CFP; image size 1932x1916: 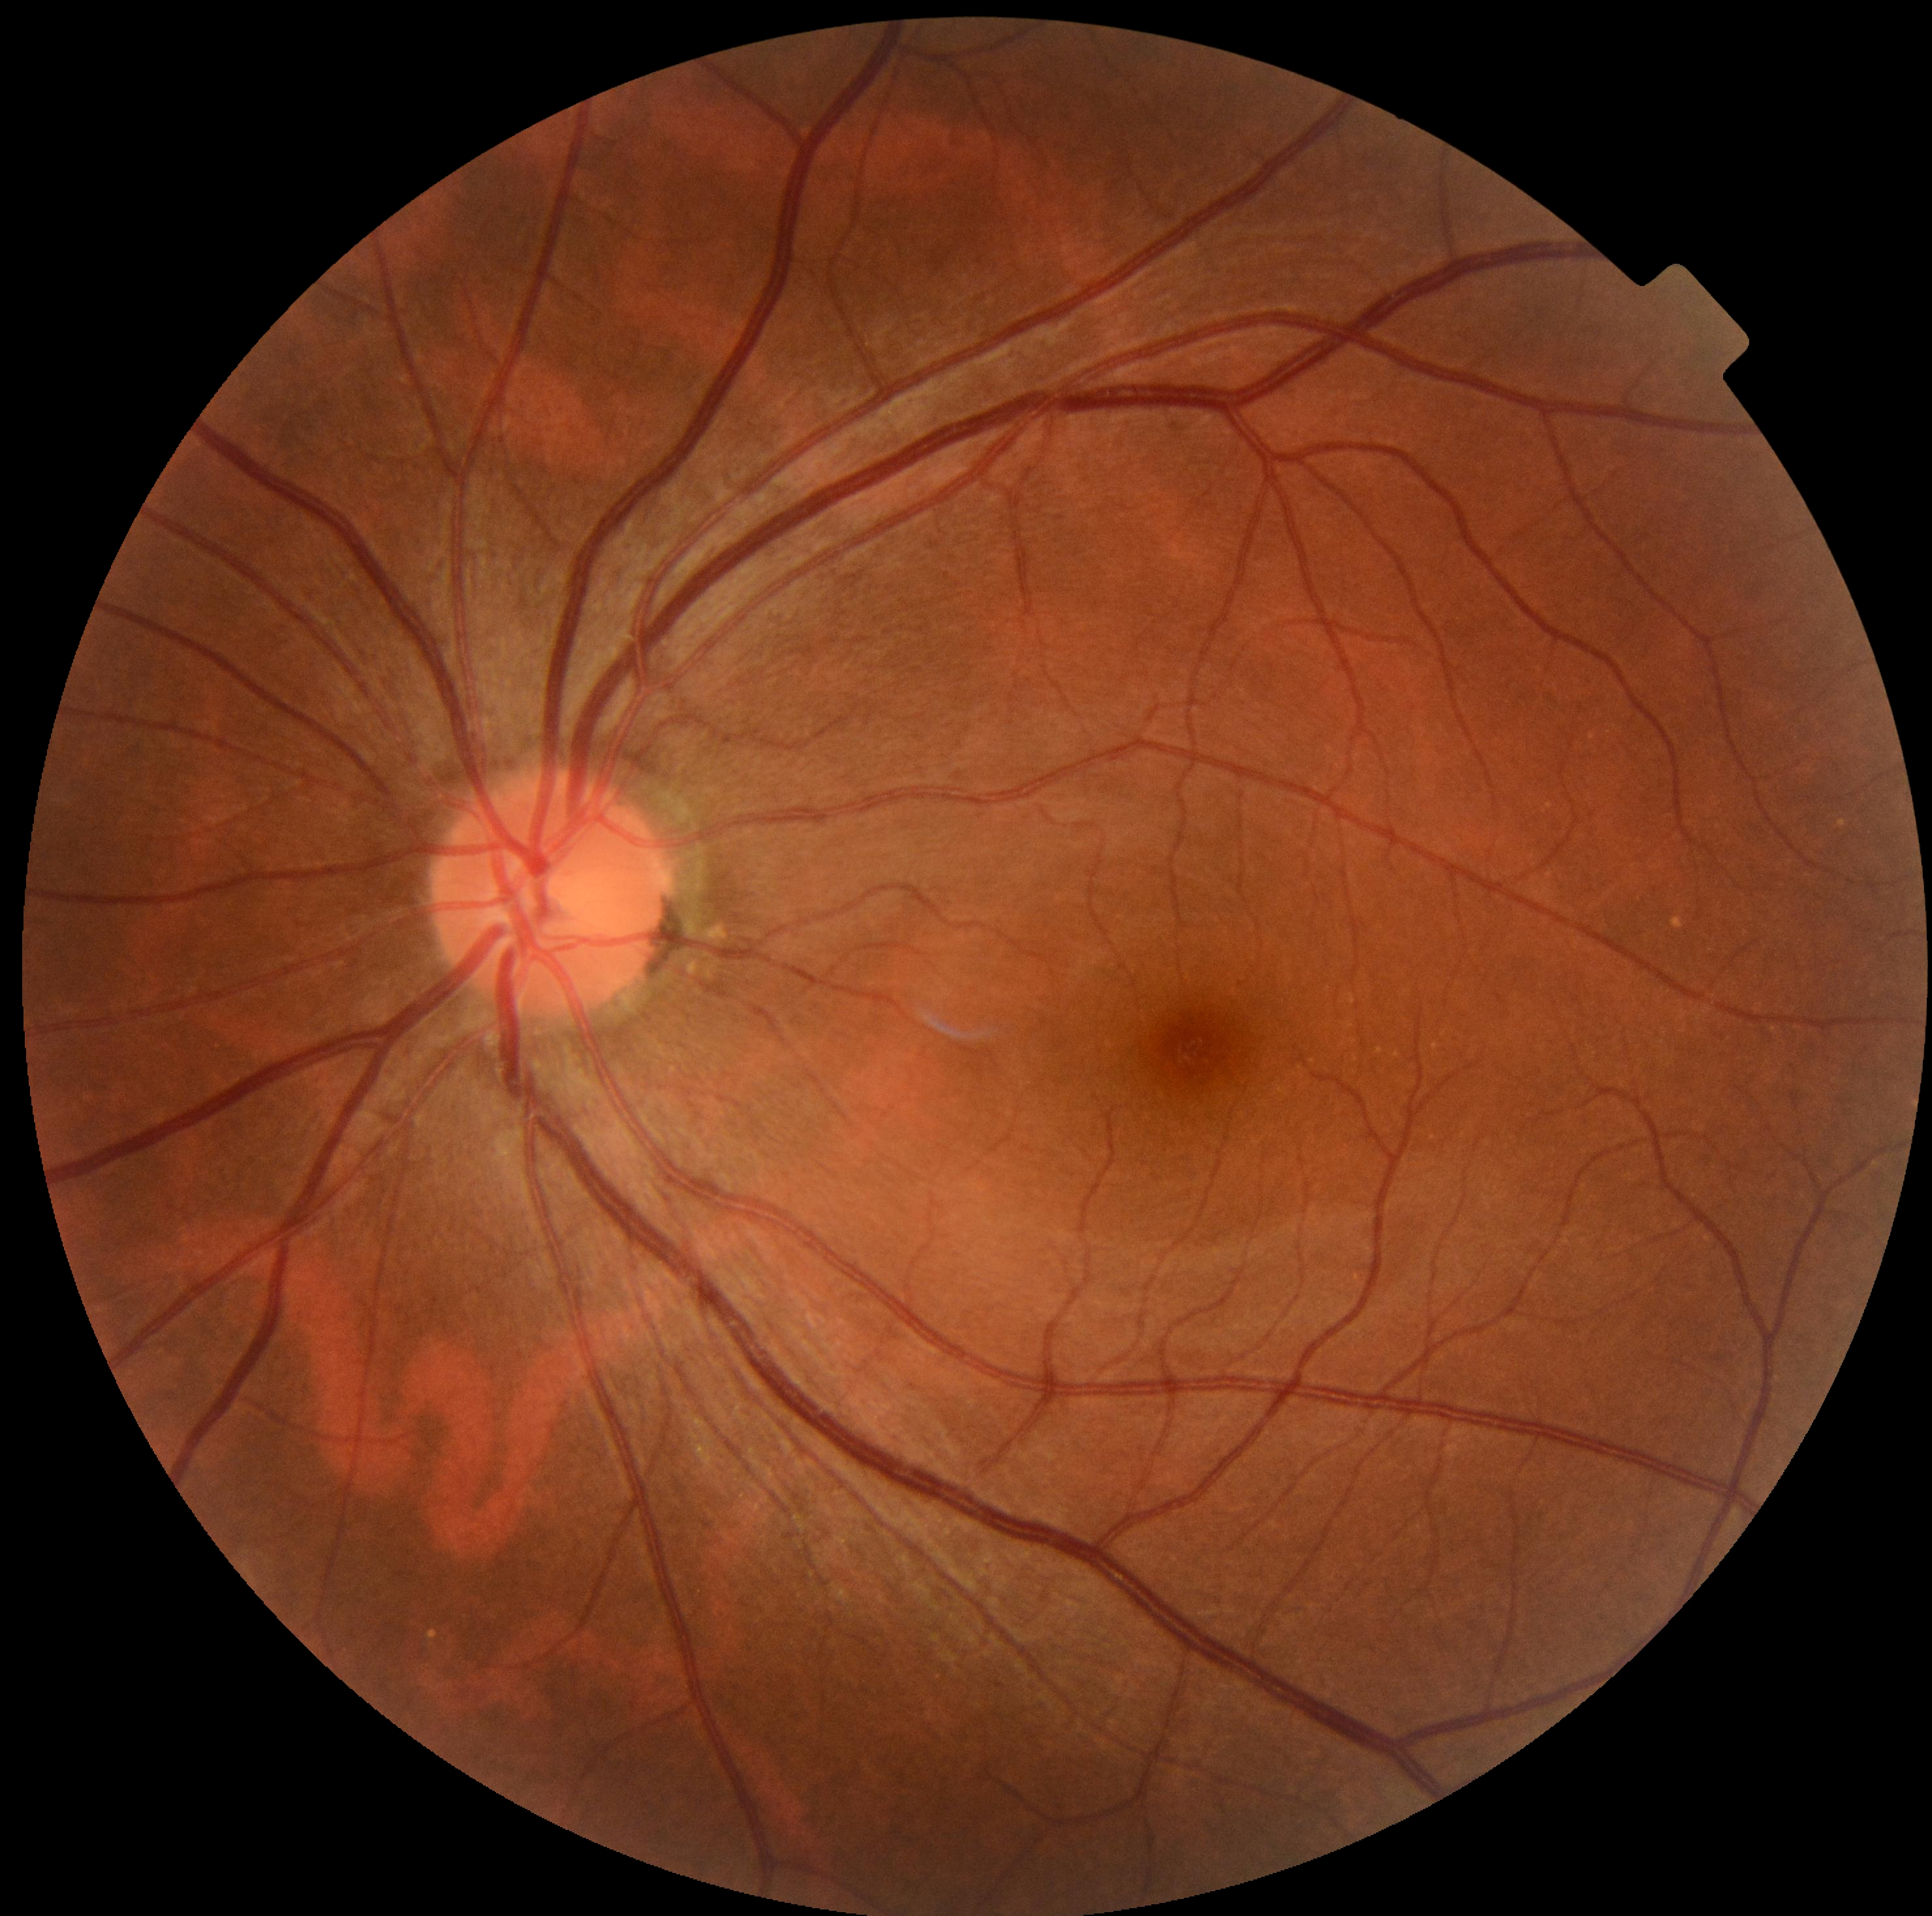 Diabetic retinopathy (DR) is no apparent diabetic retinopathy (grade 0).